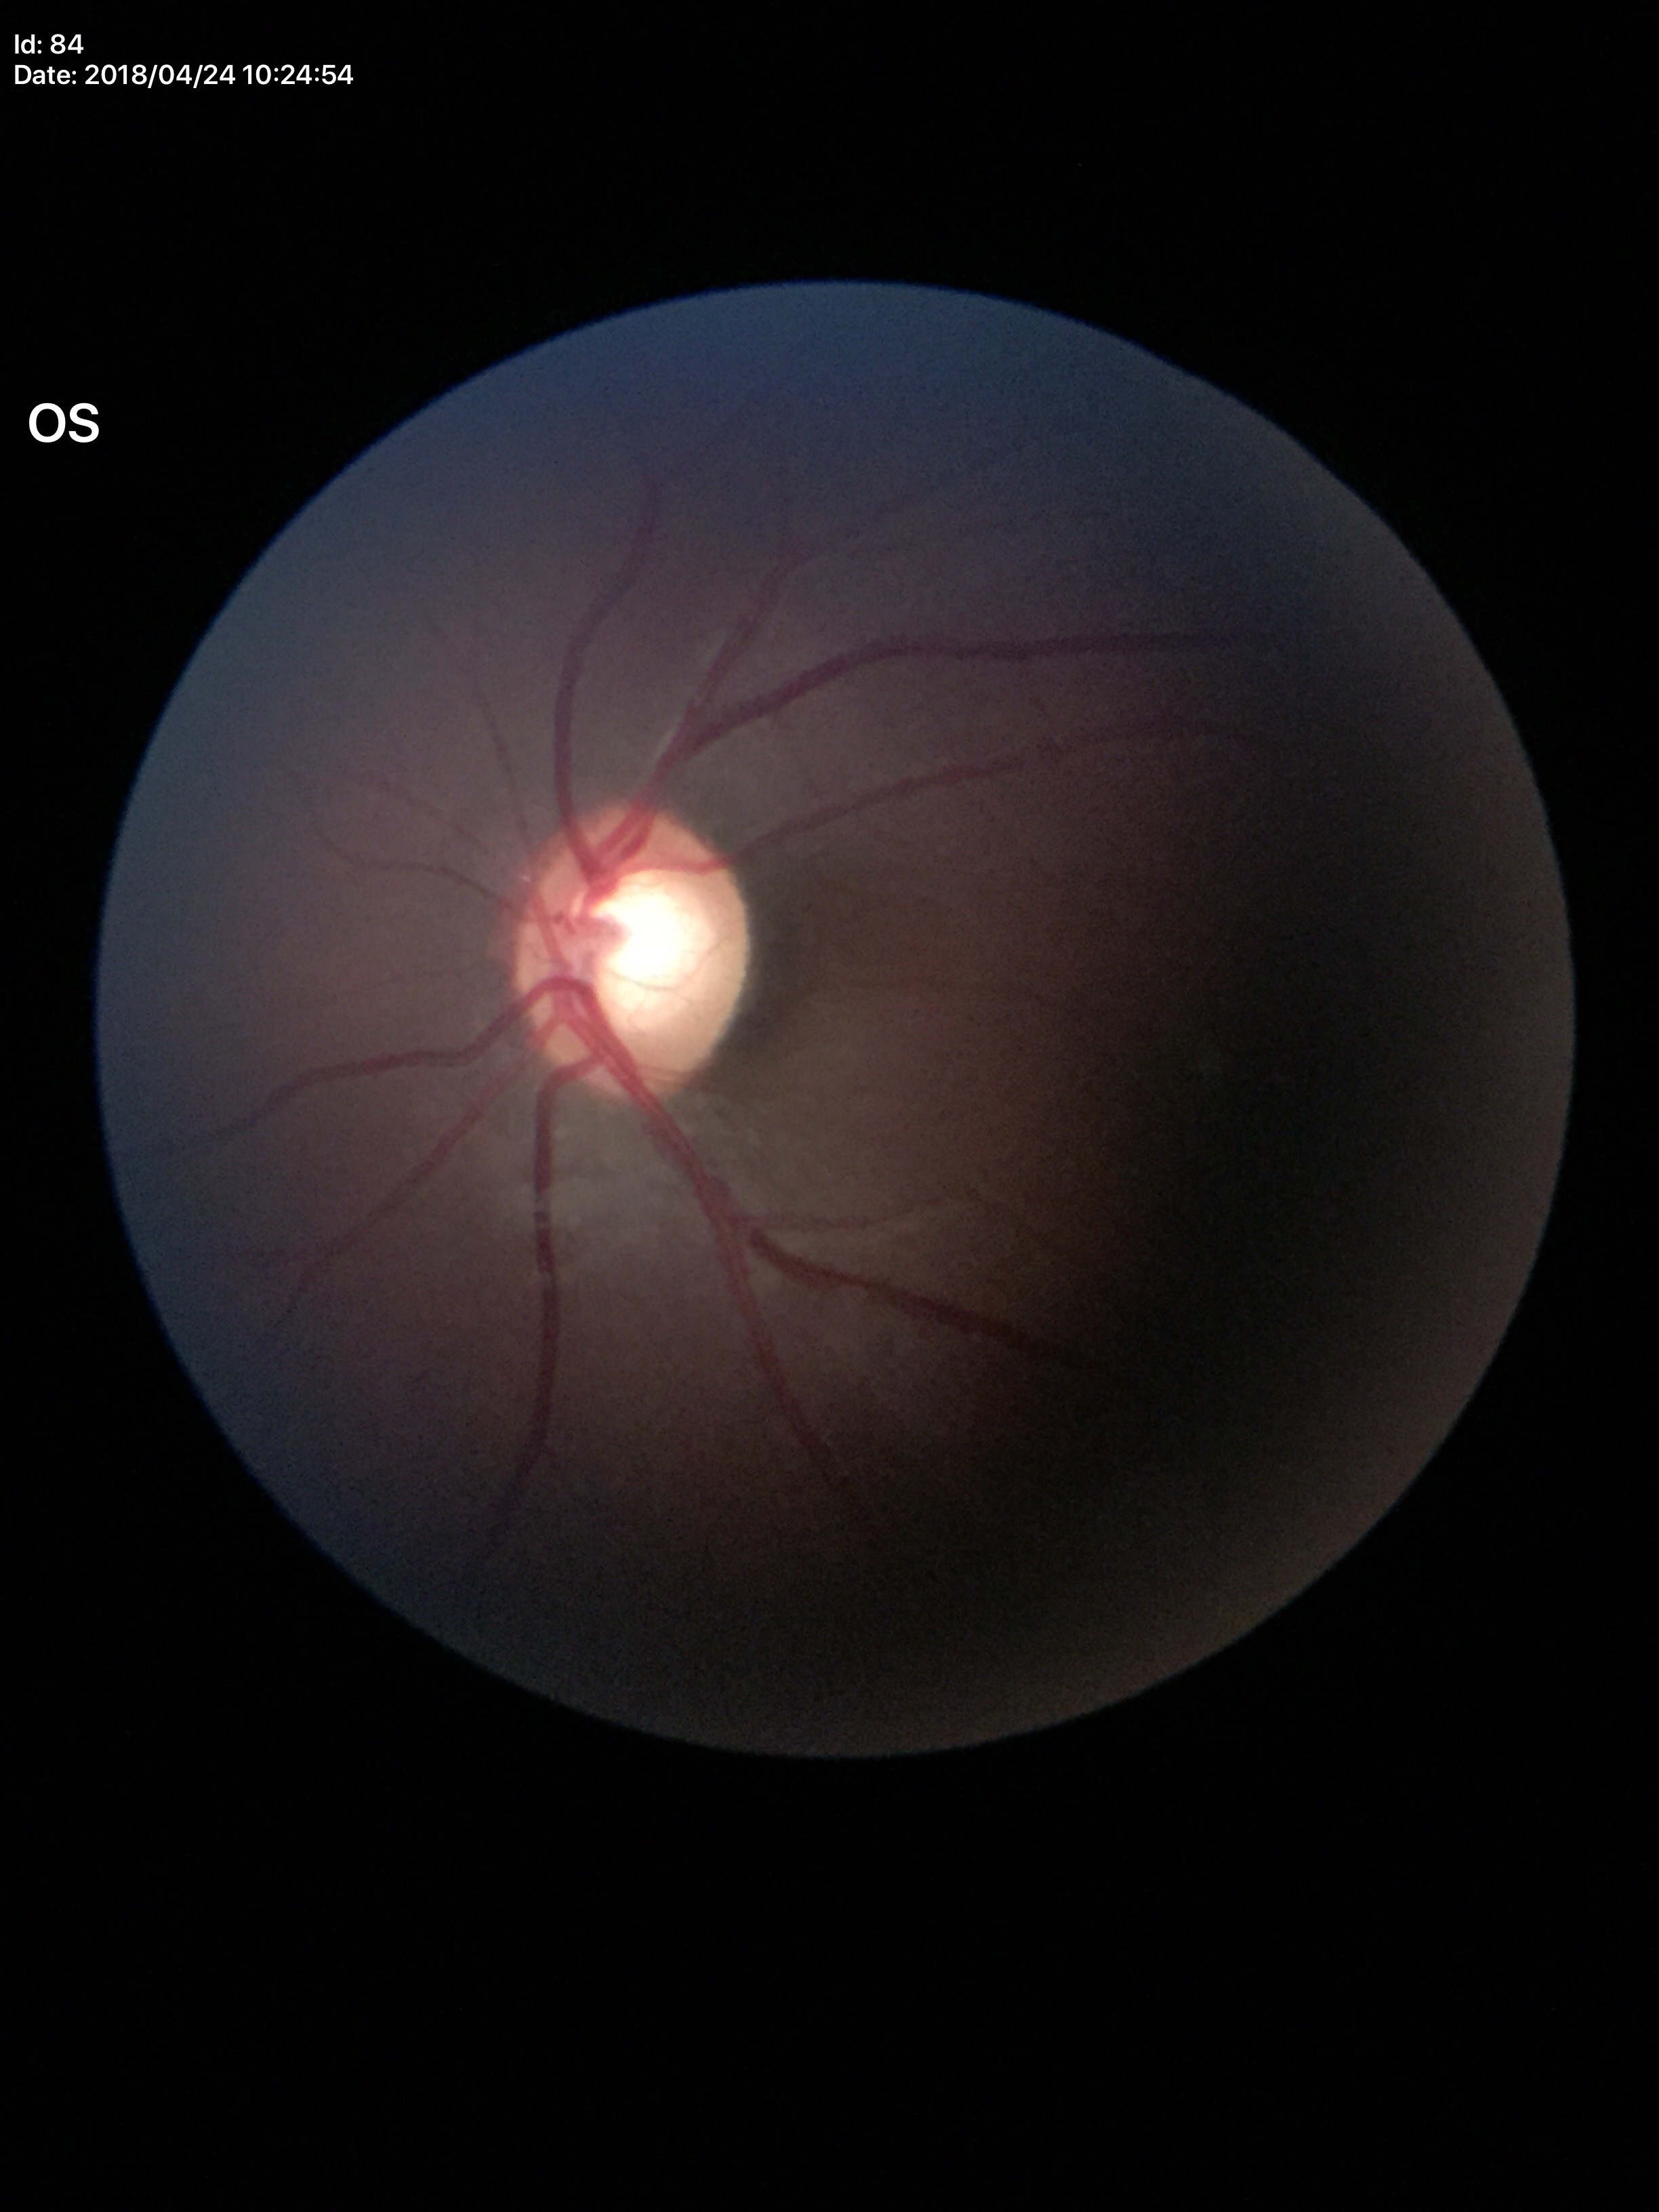
Glaucoma screening: suspect.
Vertical cup-disc ratio: 0.64.
Area C/D ratio: 0.41.